Image size 640x480; infant wide-field fundus photograph.
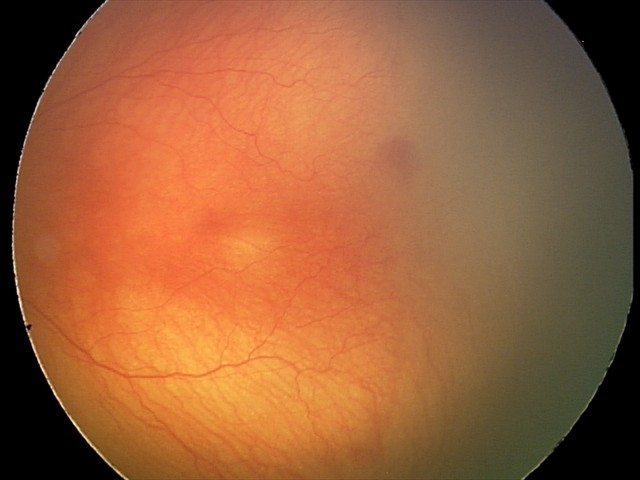

Screening examination consistent with aggressive retinopathy of prematurity (A-ROP).